Image size 2184x1690. 45° FOV. Retinal fundus photograph — 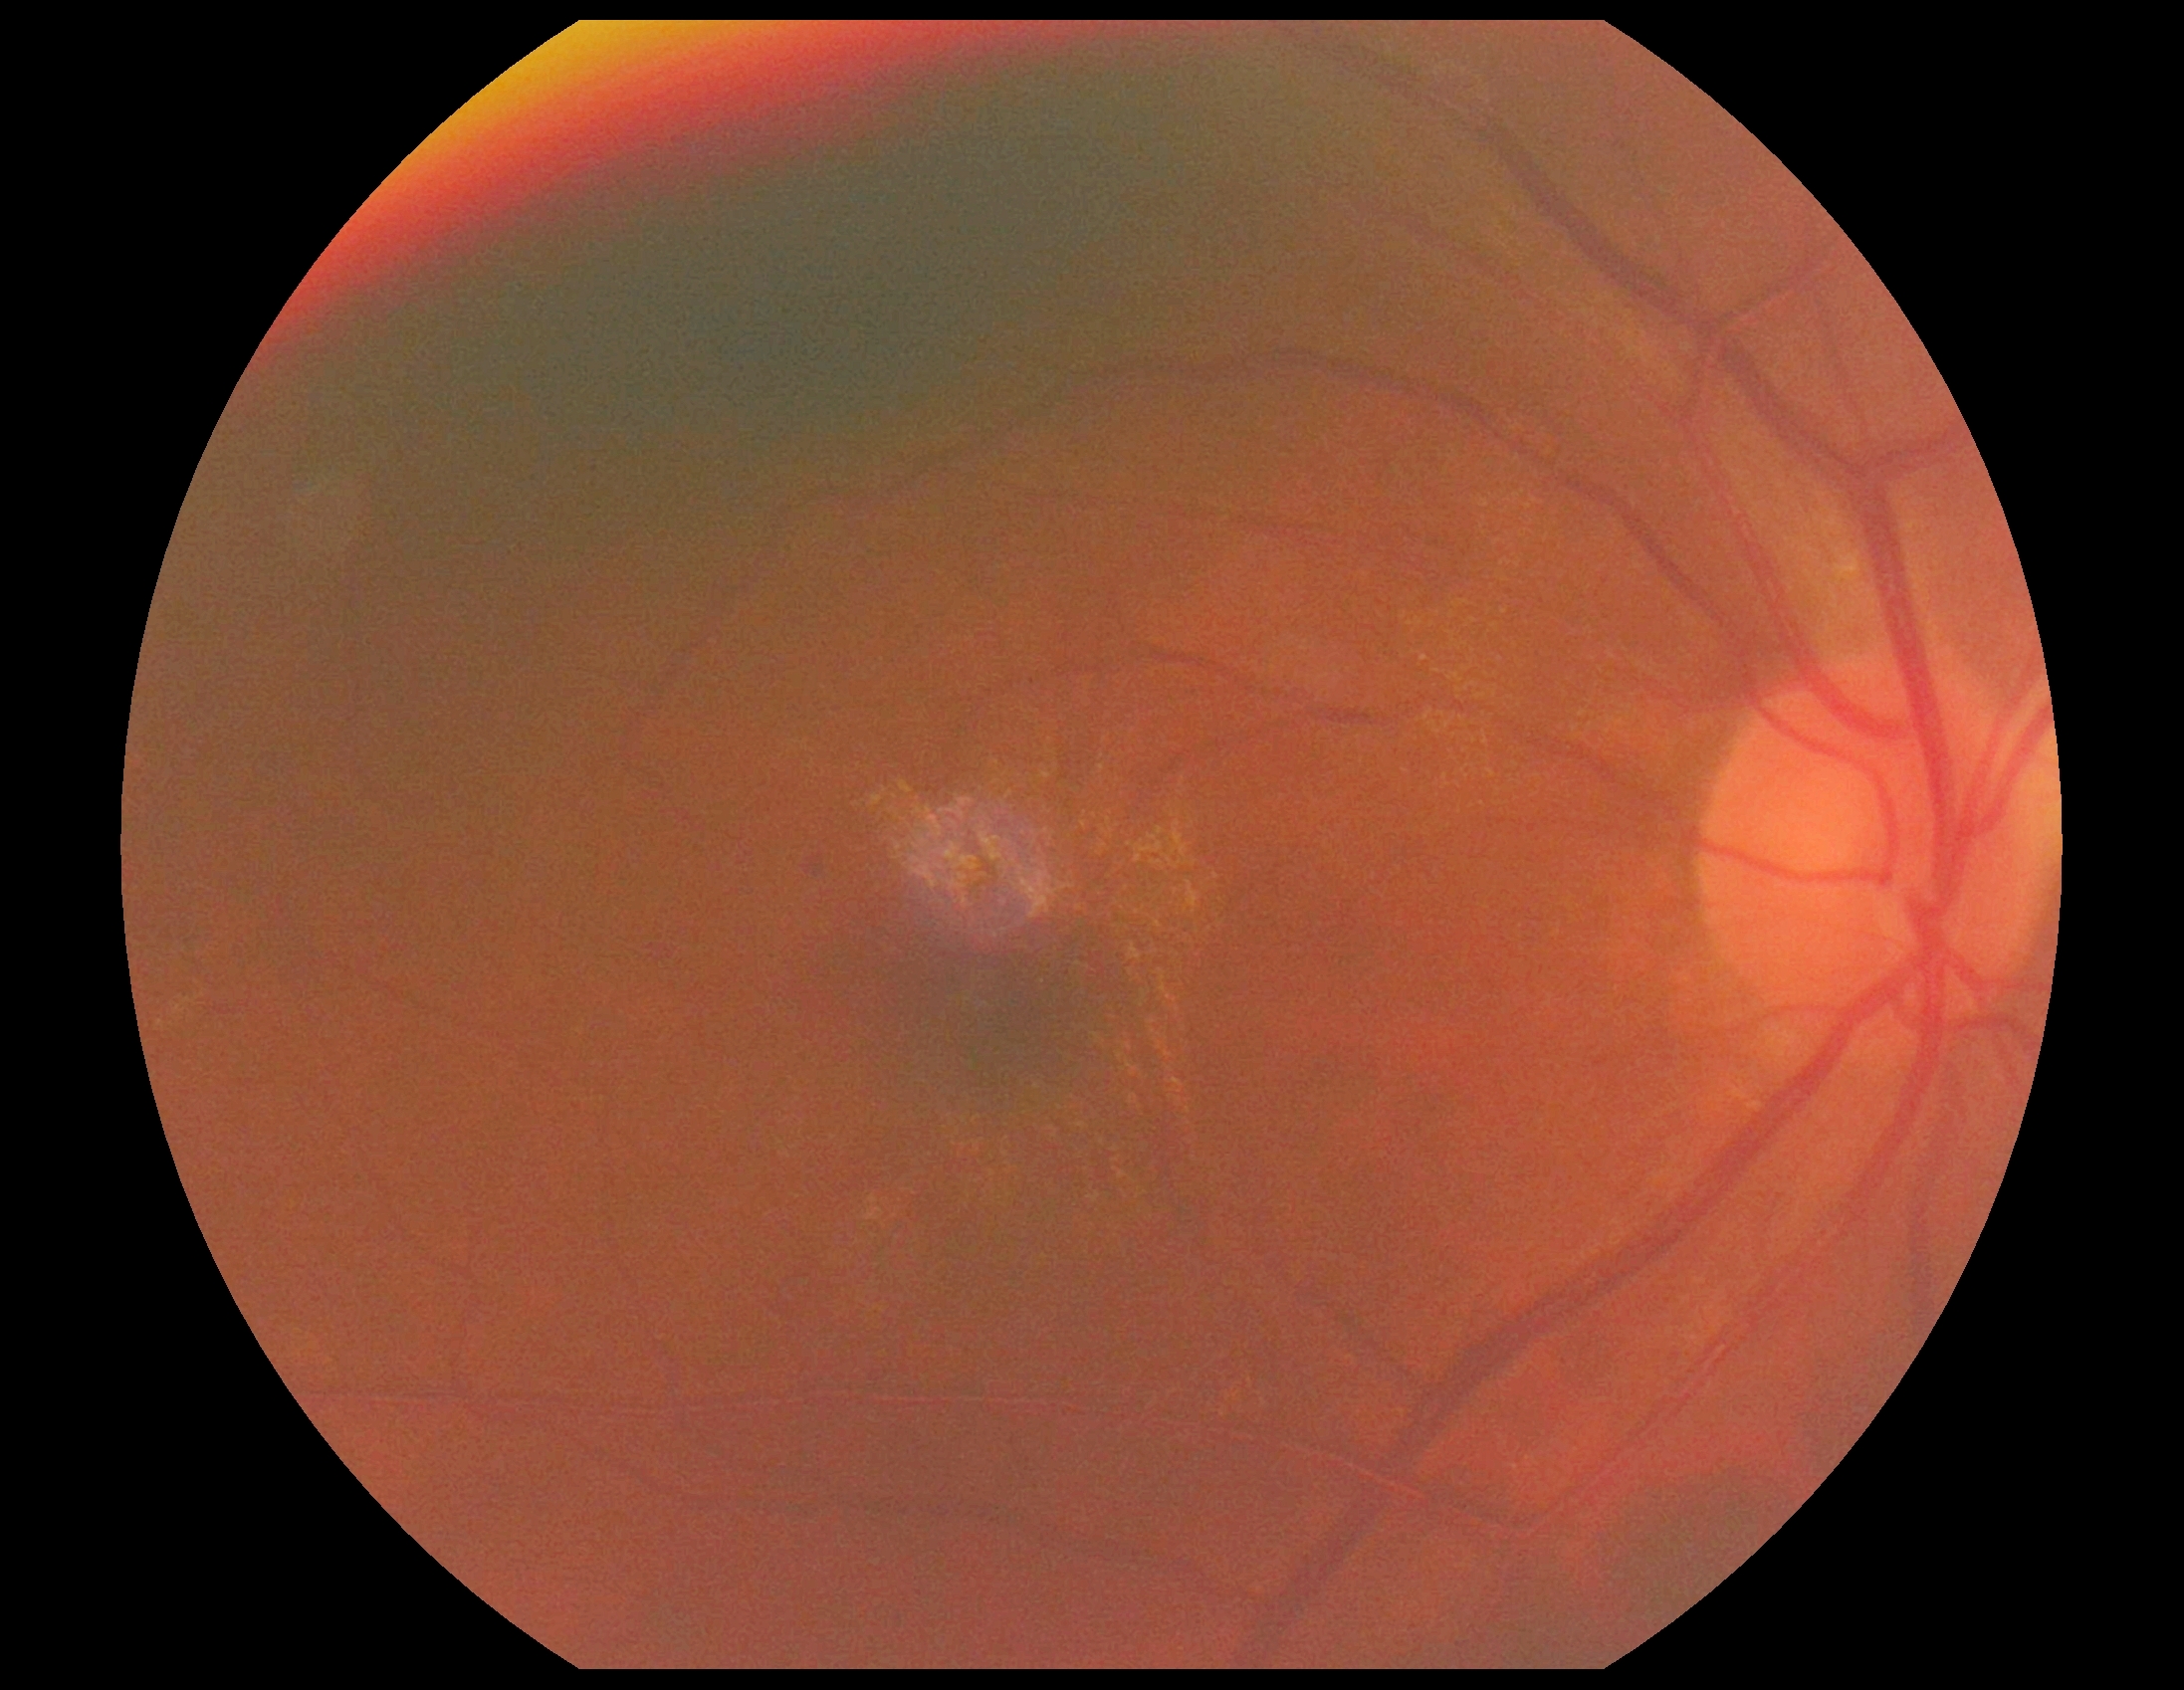
DR: mild NPDR (grade 1).